Wide-field fundus photograph from neonatal ROP screening
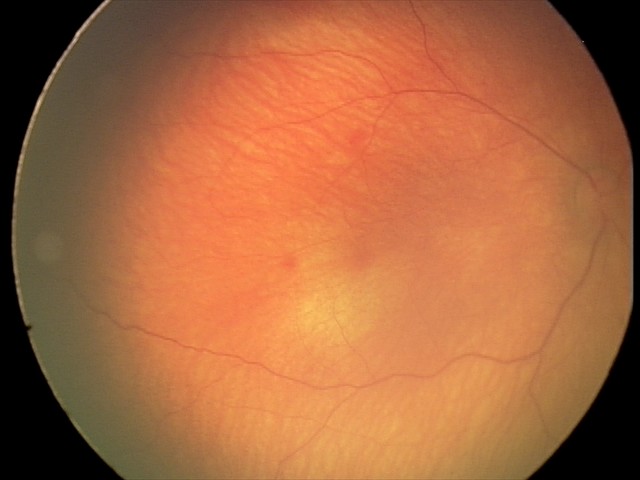 Screening examination with no abnormal retinal findings.